Color fundus photograph from a handheld portable camera: 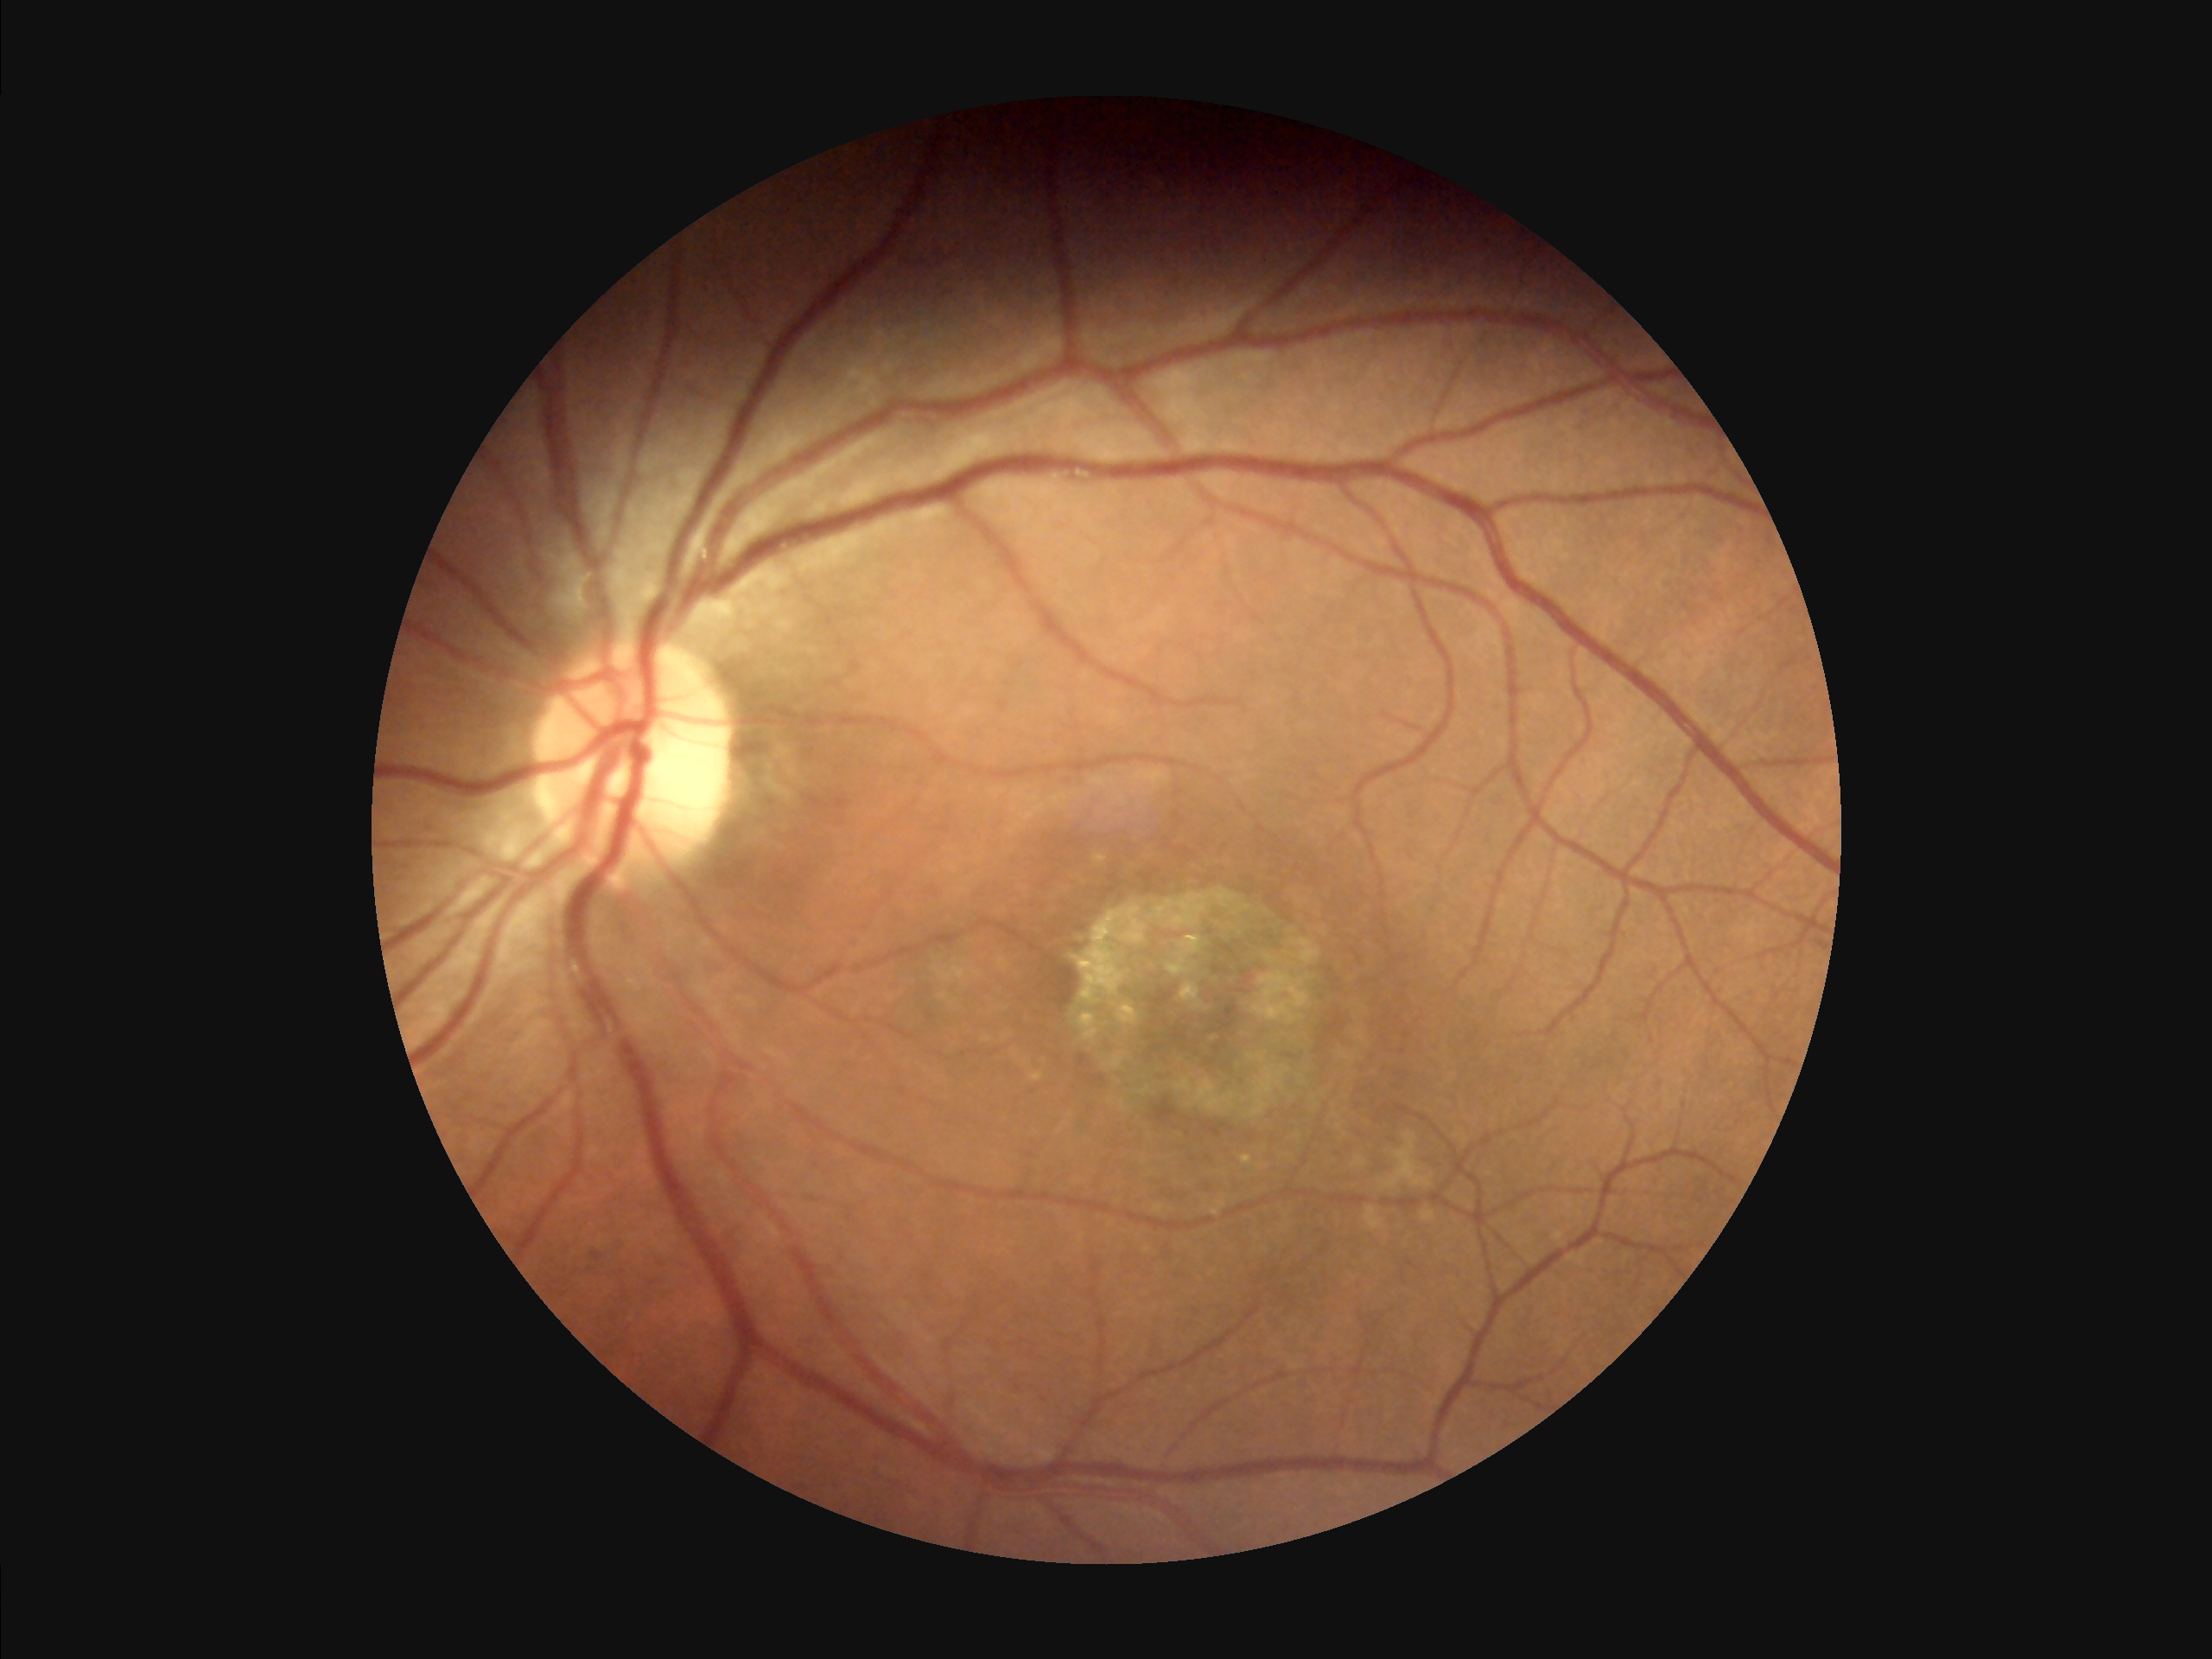
Overall: good, gradable
Illumination: uniform, no color cast
Clarity: clear with no noticeable blur